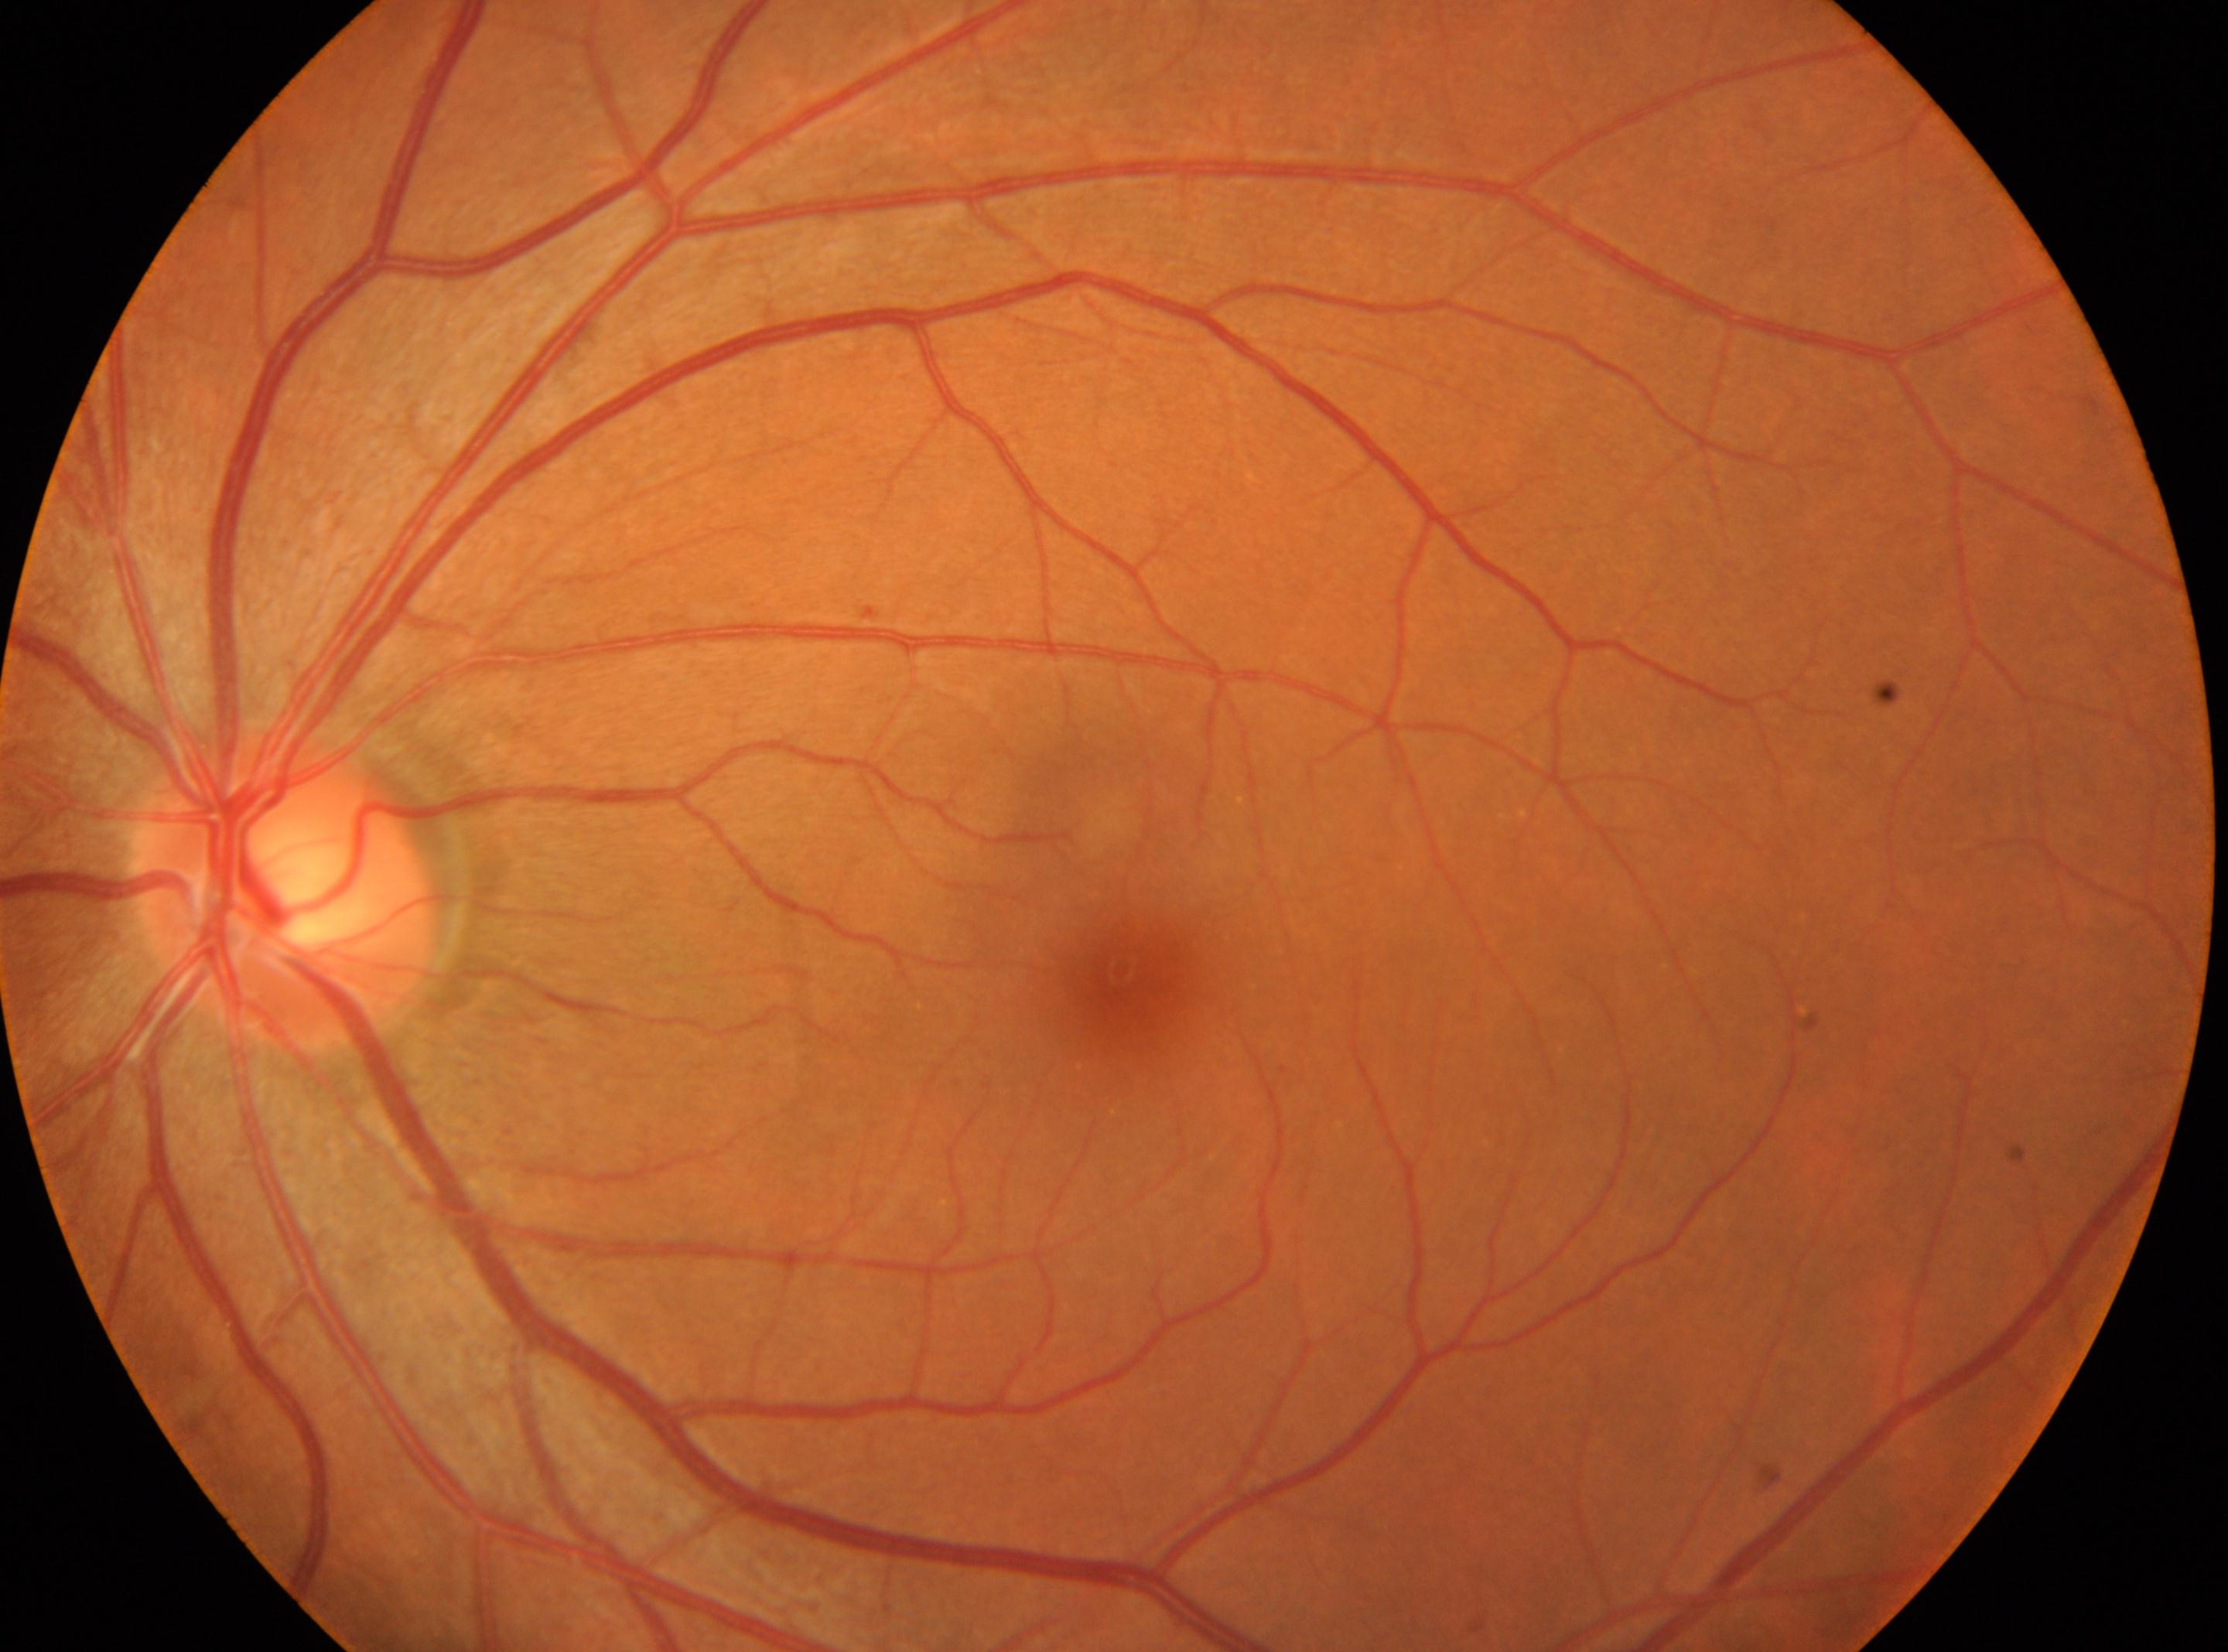
The retinopathy is classified as non-proliferative diabetic retinopathy.
Imaged eye: OS.
Disc center located at 284px, 894px.
Macula center located at 1120px, 973px.
Diabetic retinopathy (DR): grade 1 (mild NPDR).